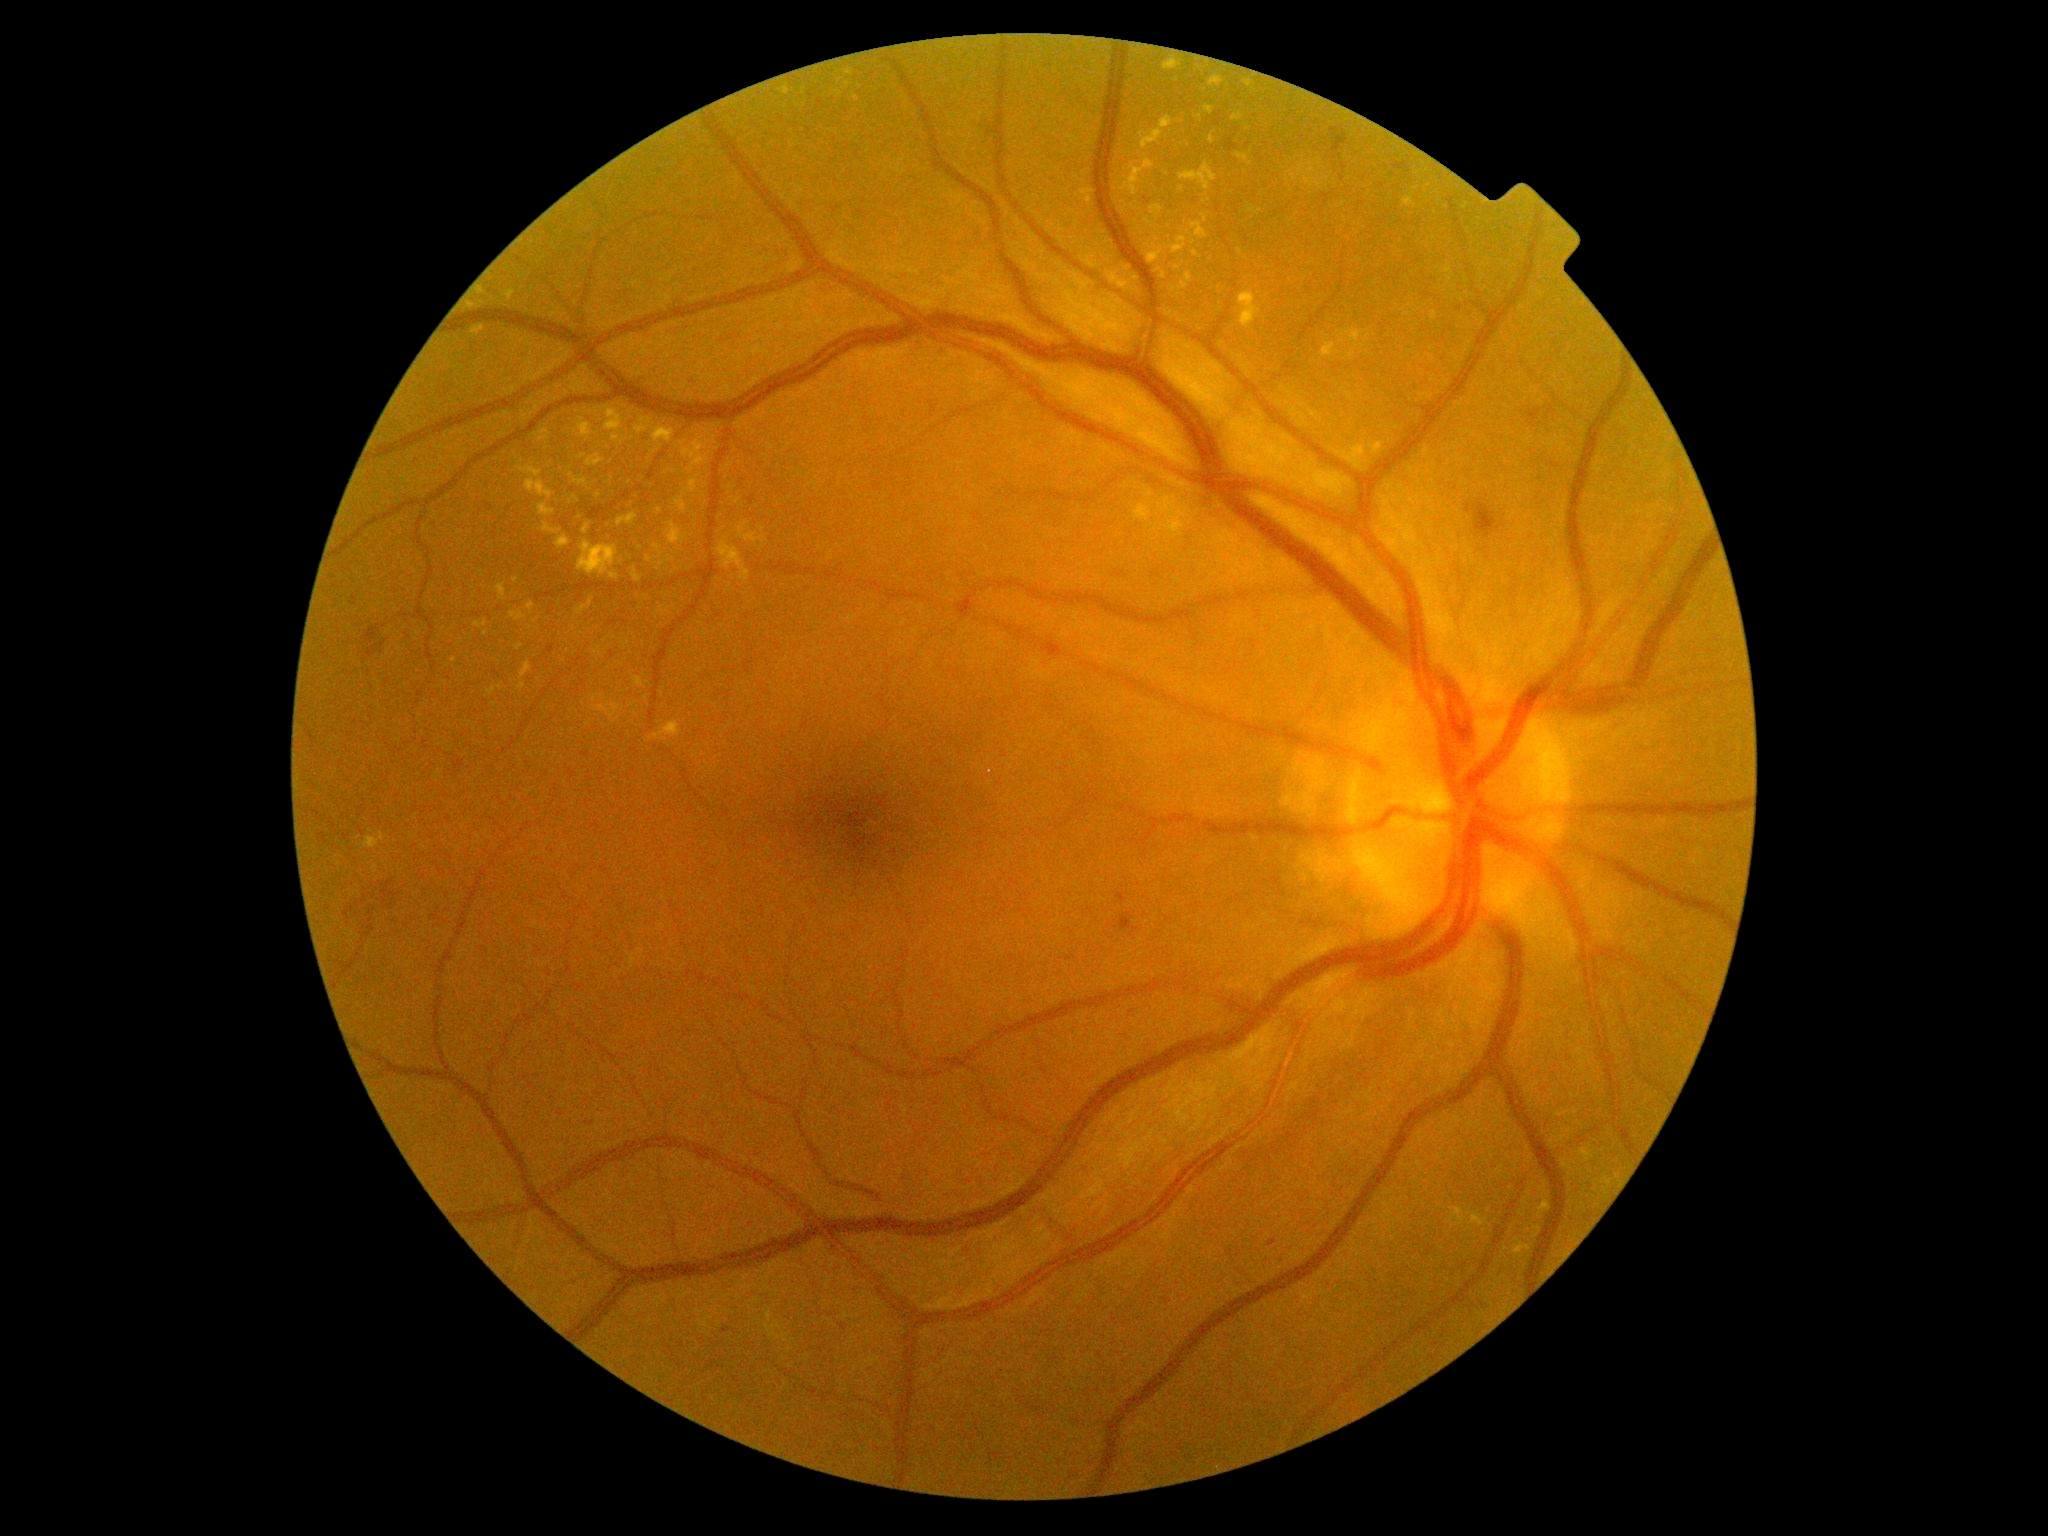
Diabetic retinopathy grade: 2; non-proliferative diabetic retinopathy
Lesions identified (partial list):
hard exudates (continued): (1246,205,1261,214); (578,541,620,581); (1132,207,1140,211); (1321,343,1335,359); (363,833,386,849); (477,288,488,296); (525,479,555,499); (1147,244,1163,264); (1185,273,1193,281); (1209,76,1225,88); (486,687,497,697); (665,558,675,562); (541,522,571,549)
Hard exudates (small, approximate centers) near 589:724; 848:85; 1181:121; 1137:279; 519:647; 633:705; 596:411